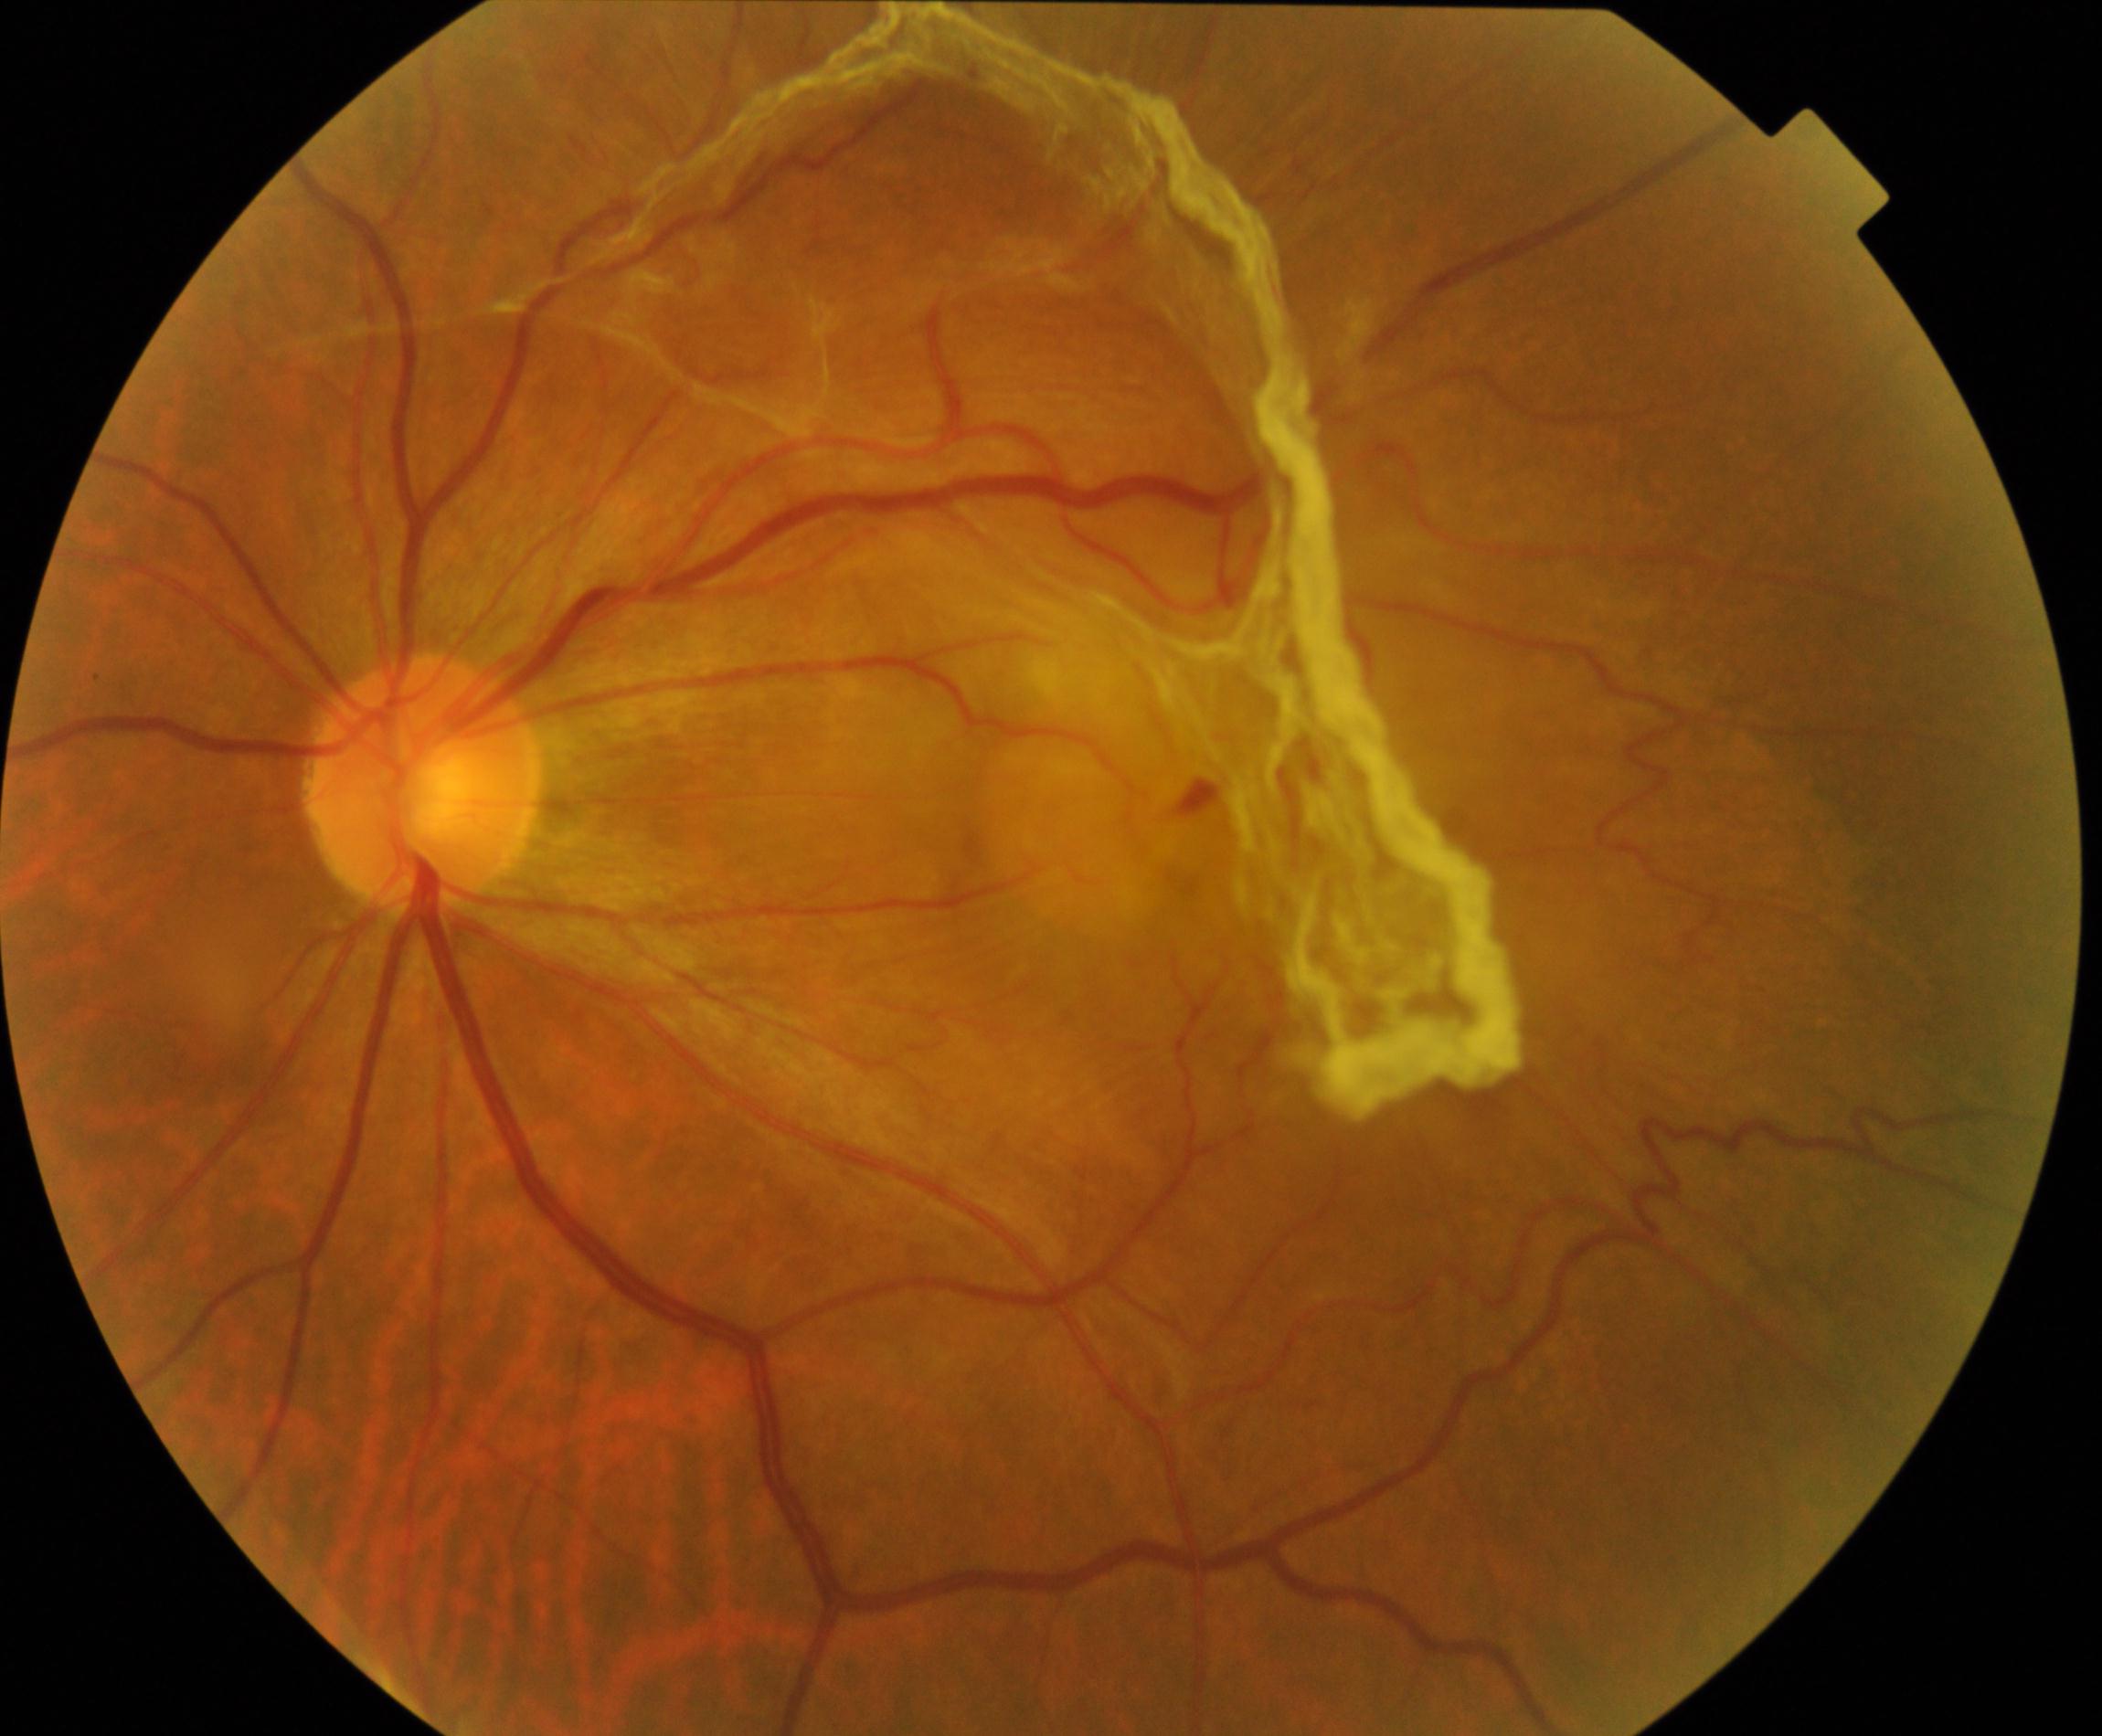
Fundus image consistent with fibrosis. Features include irregular grayish-white opacification, often with distortion of the retinal vasculature, crossing the vessel arcades.